Posterior pole photograph · FOV: 45 degrees · nonmydriatic fundus photograph · 848 x 848 pixels · NIDEK AFC-230 fundus camera — 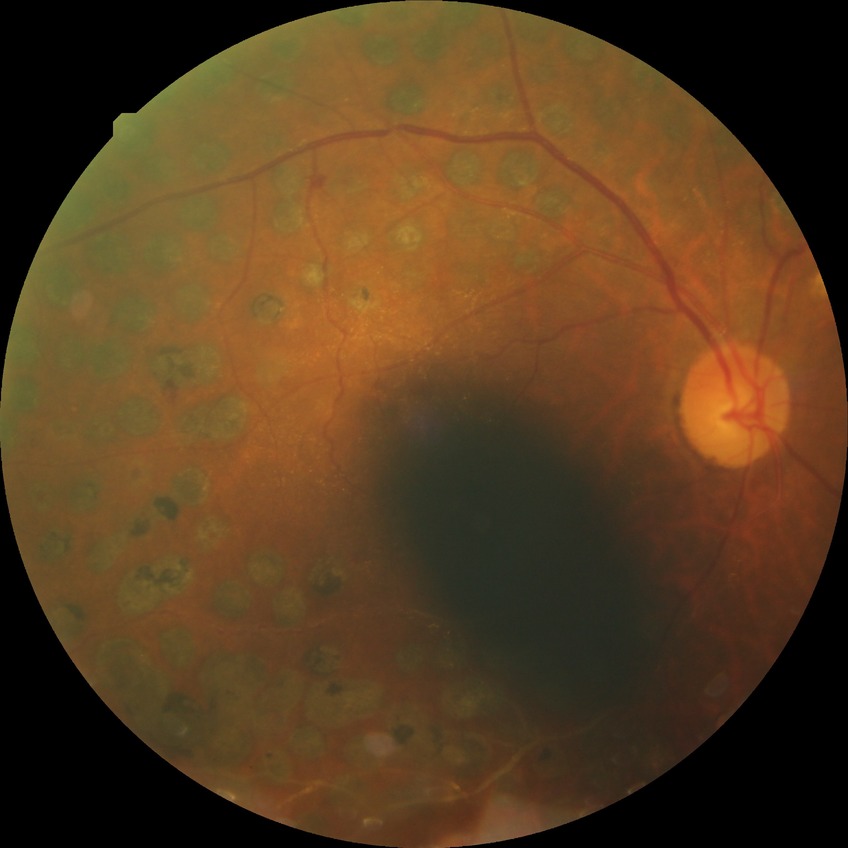 Annotations:
- Davis grade — PDR